UWF retinal mosaic
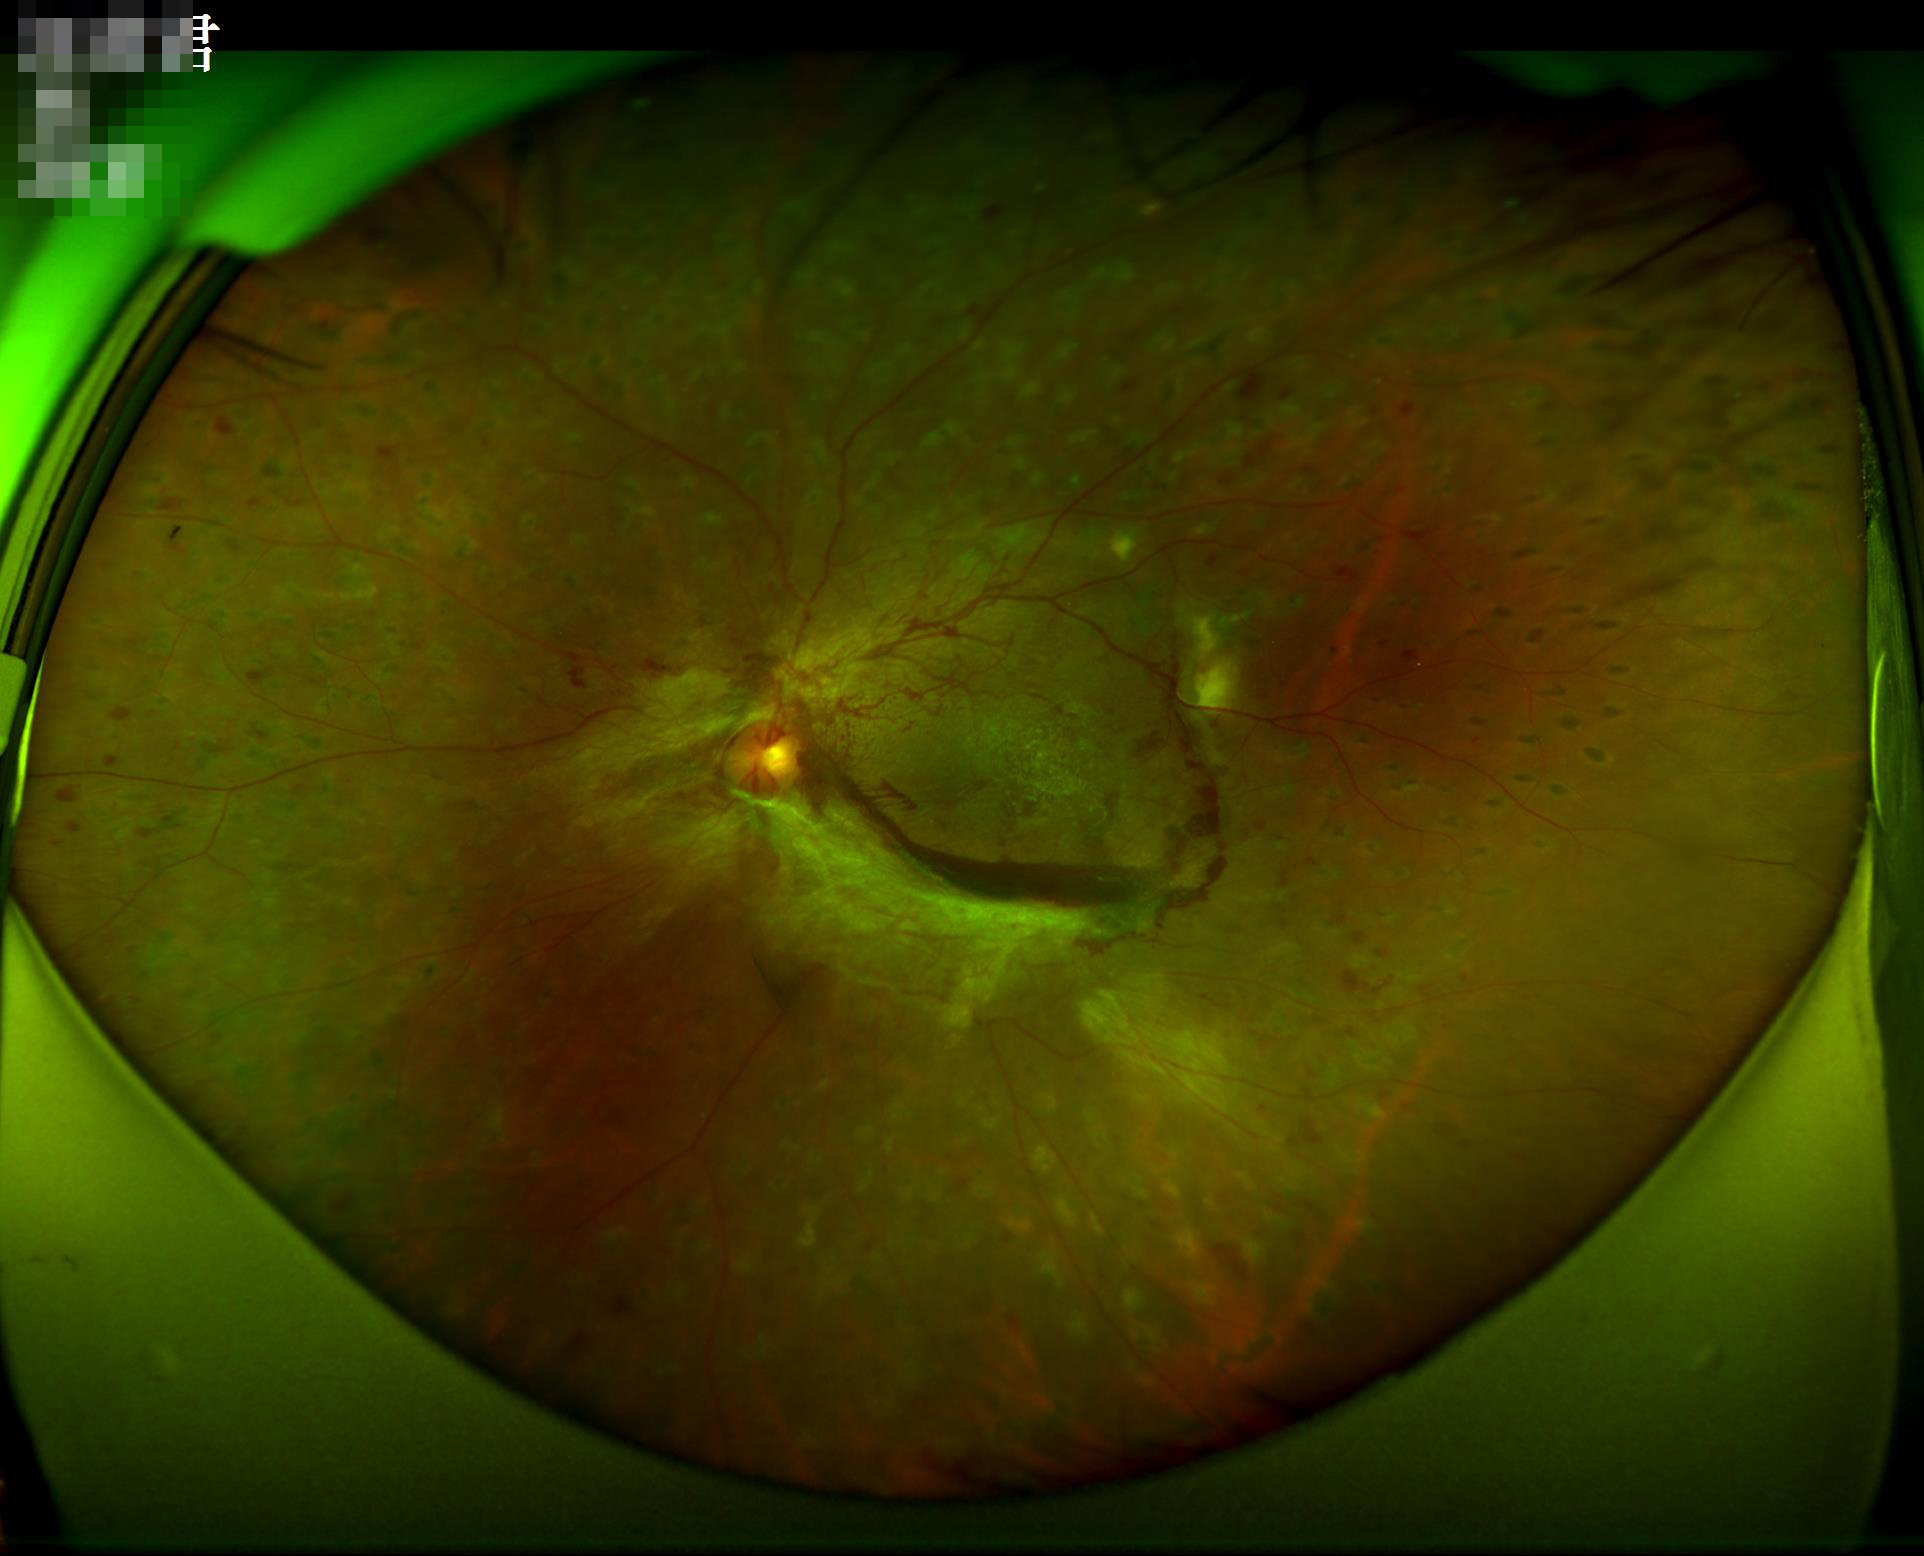   contrast: vessels and details readily distinguishable
  illumination: no over- or under-exposure
  clarity: noticeable blur in the optic disc, vessels, or background
  overall_quality: poor and difficult to use diagnostically